Camera: Clarity RetCam 3 (130° FOV); infant wide-field fundus photograph; 640 by 480 pixels.
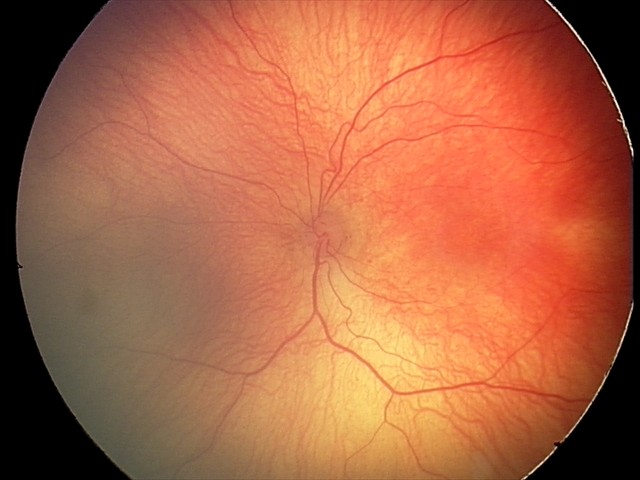

Plus disease absent. From an examination with diagnosis of ROP stage 2.